1932x1916px:
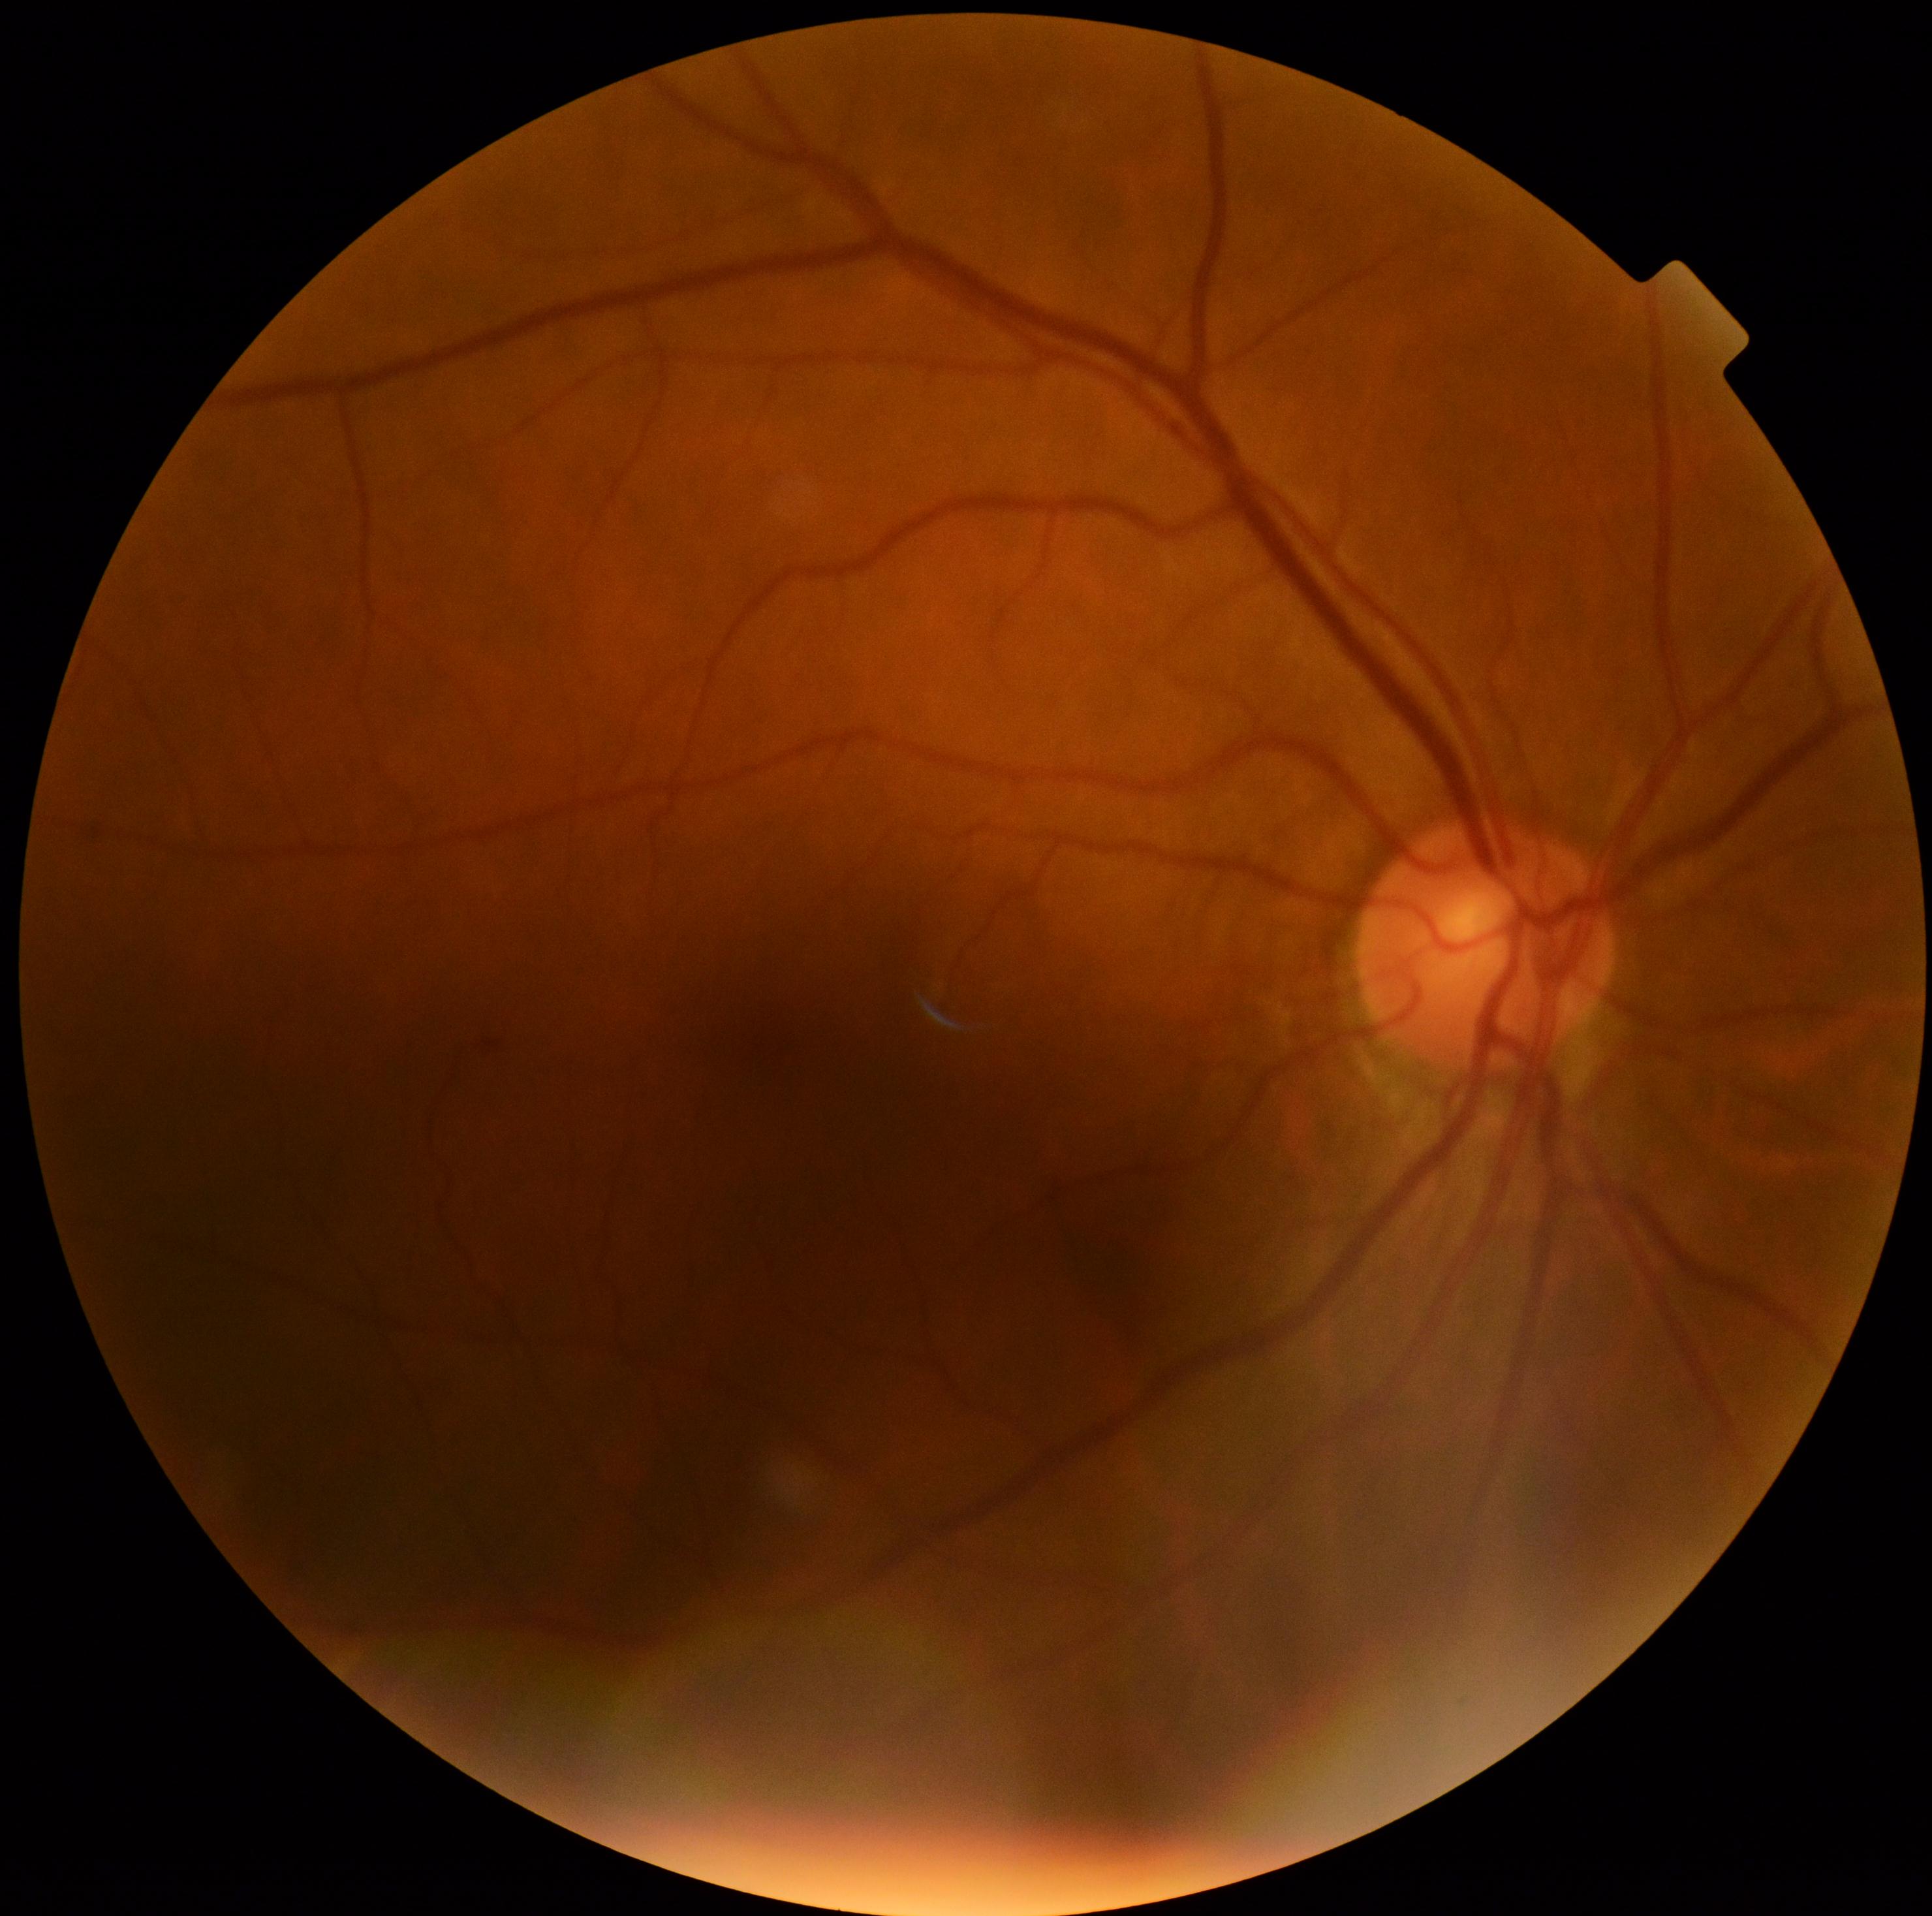
DR severity: mild non-proliferative diabetic retinopathy (grade 1) — presence of microaneurysms only.